Diabetic retinopathy graded by the modified Davis classification, without pupil dilation, retinal fundus photograph:
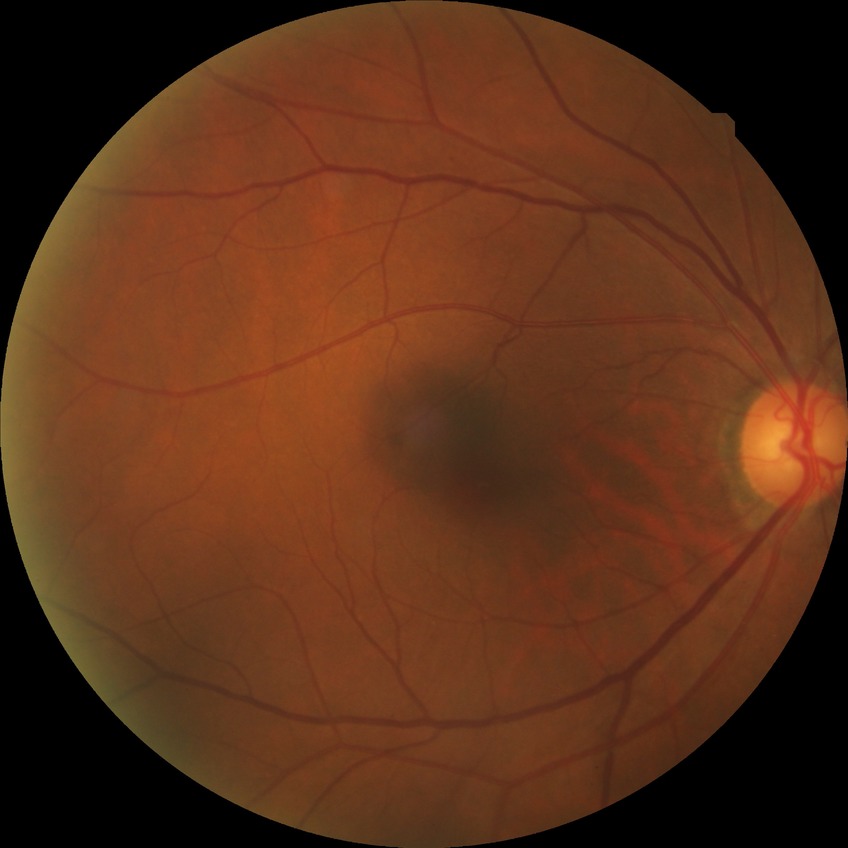
DR grade=NDR; DR impression=no DR findings.